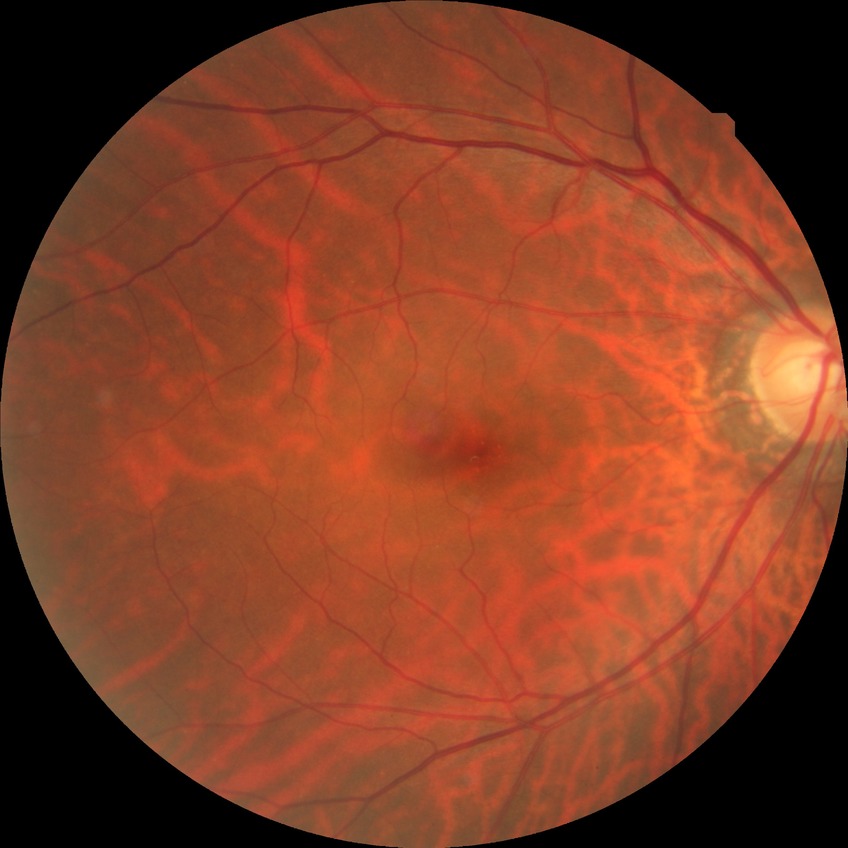 {"davis_grade": "no diabetic retinopathy (NDR)"}